1932x1910px · 45-degree field of view · color fundus image
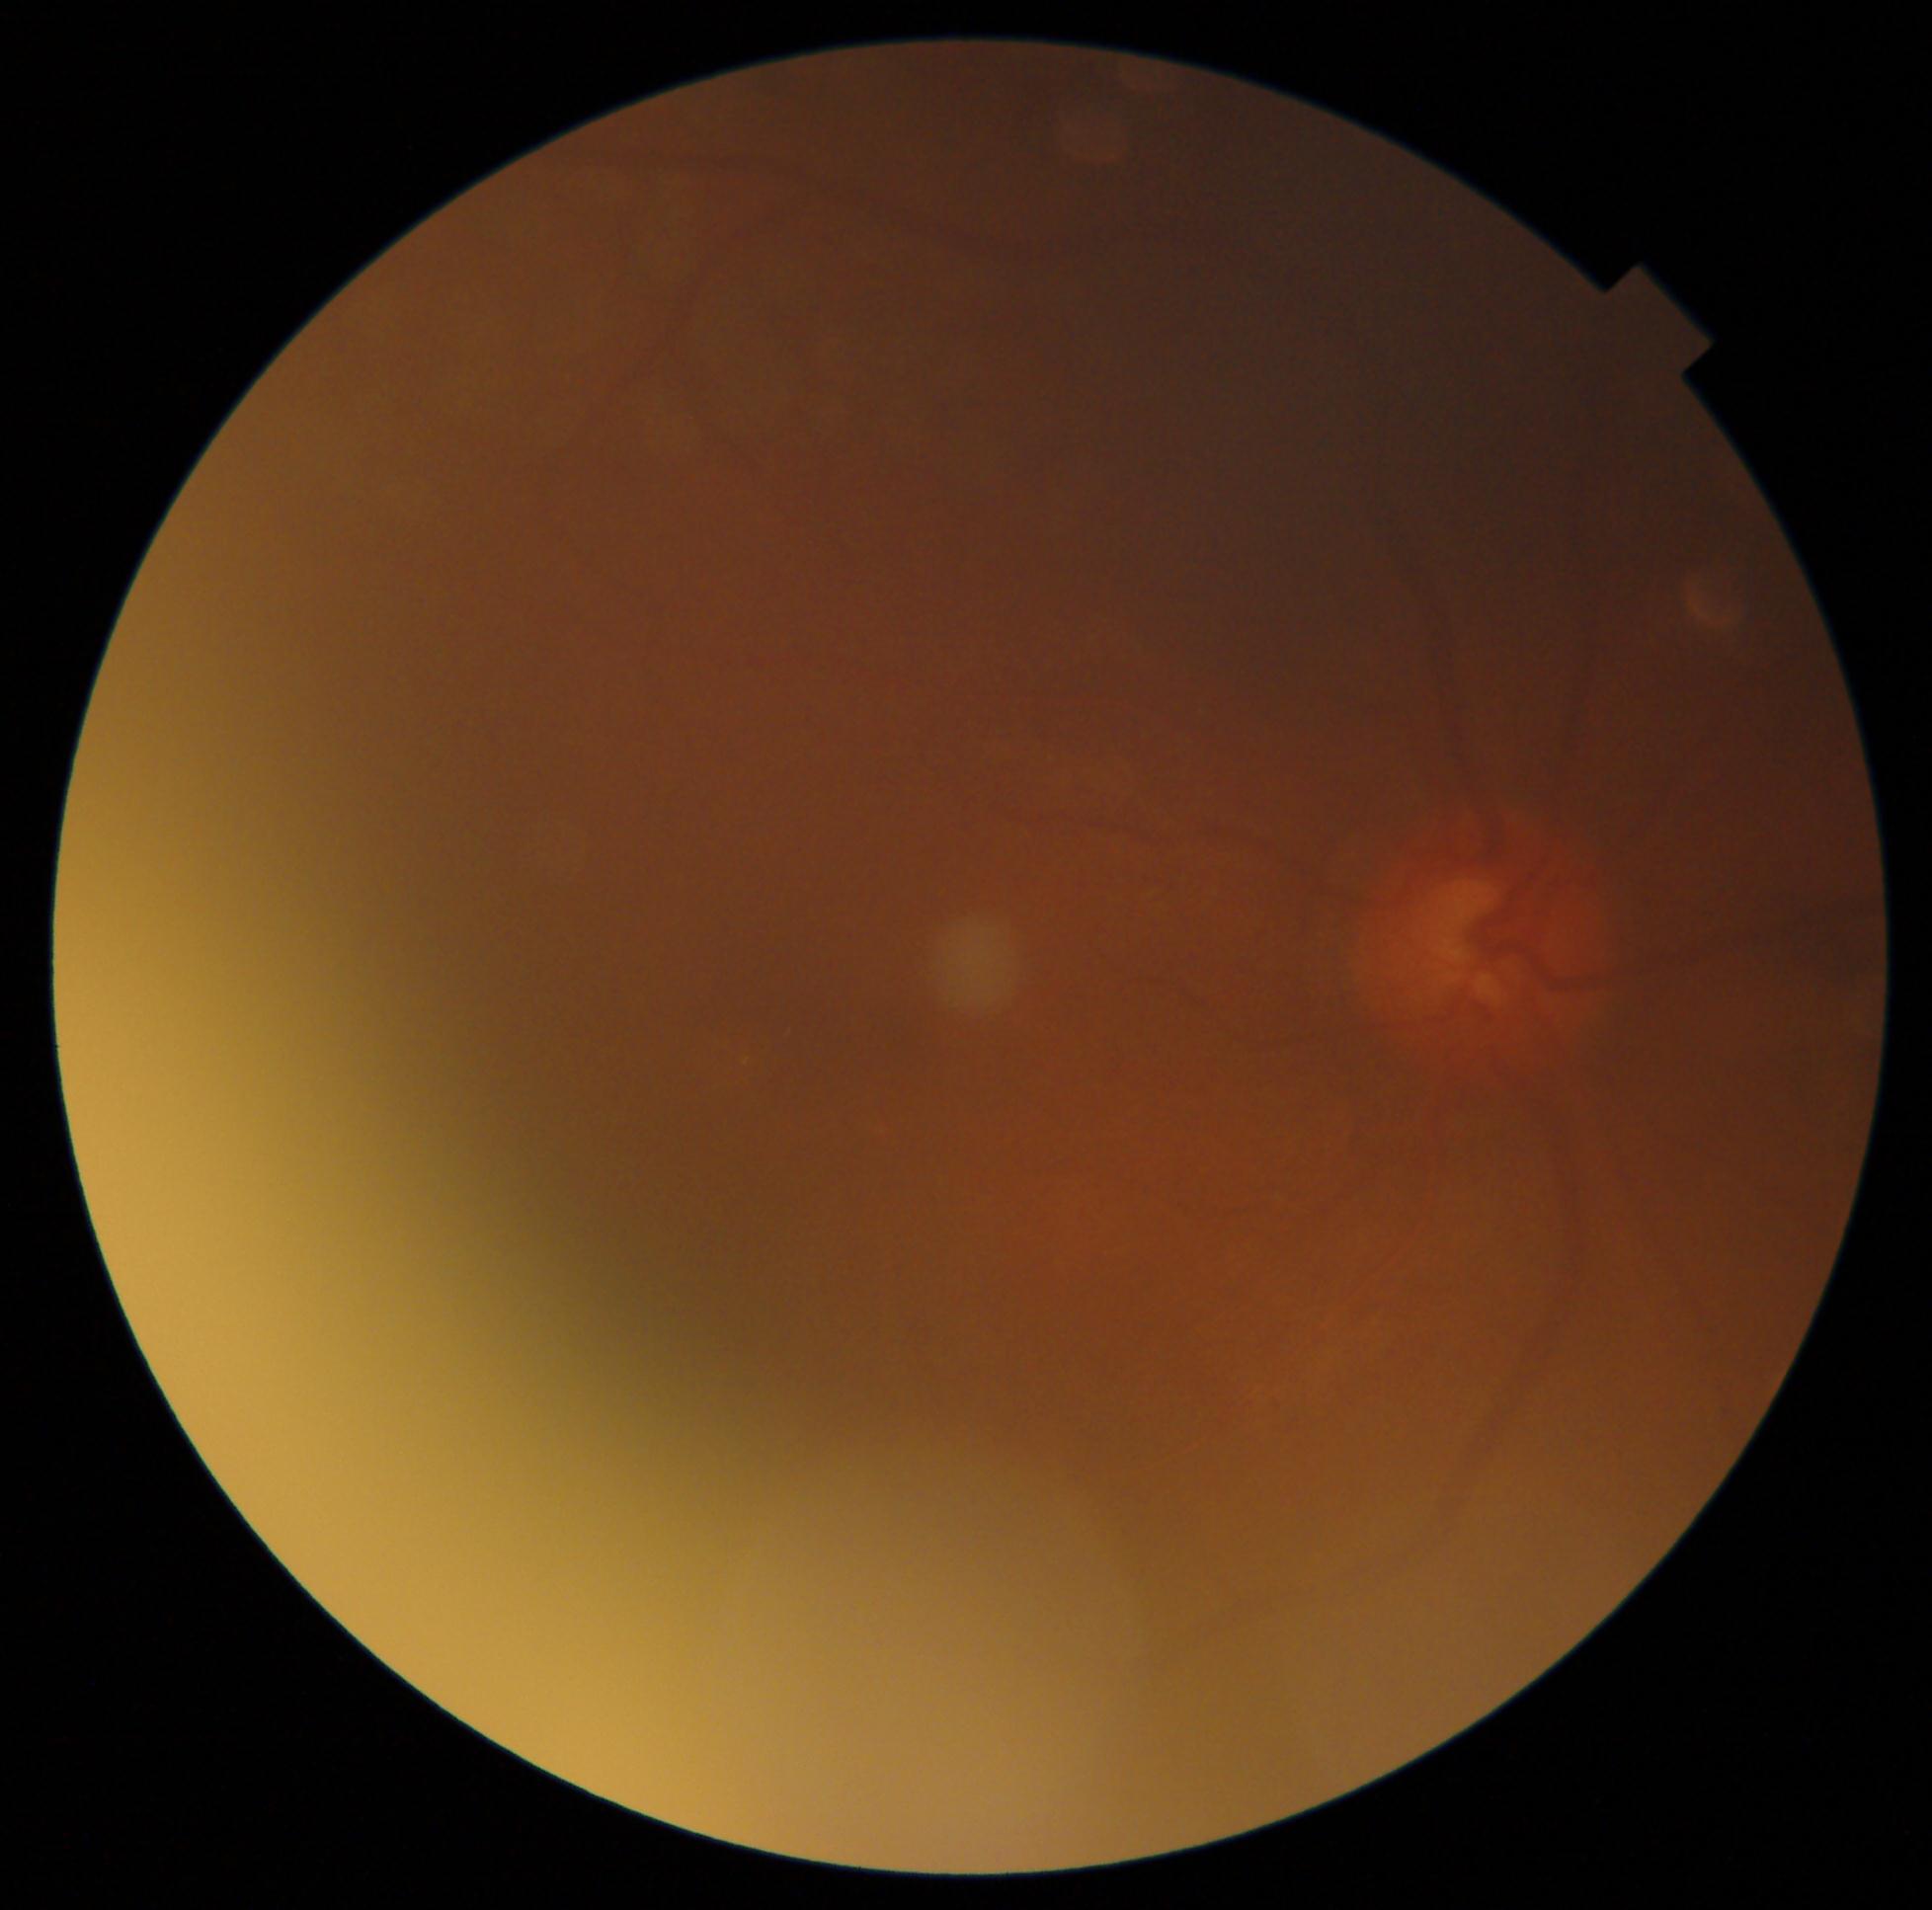

DR grade is 0 — no visible signs of diabetic retinopathy.